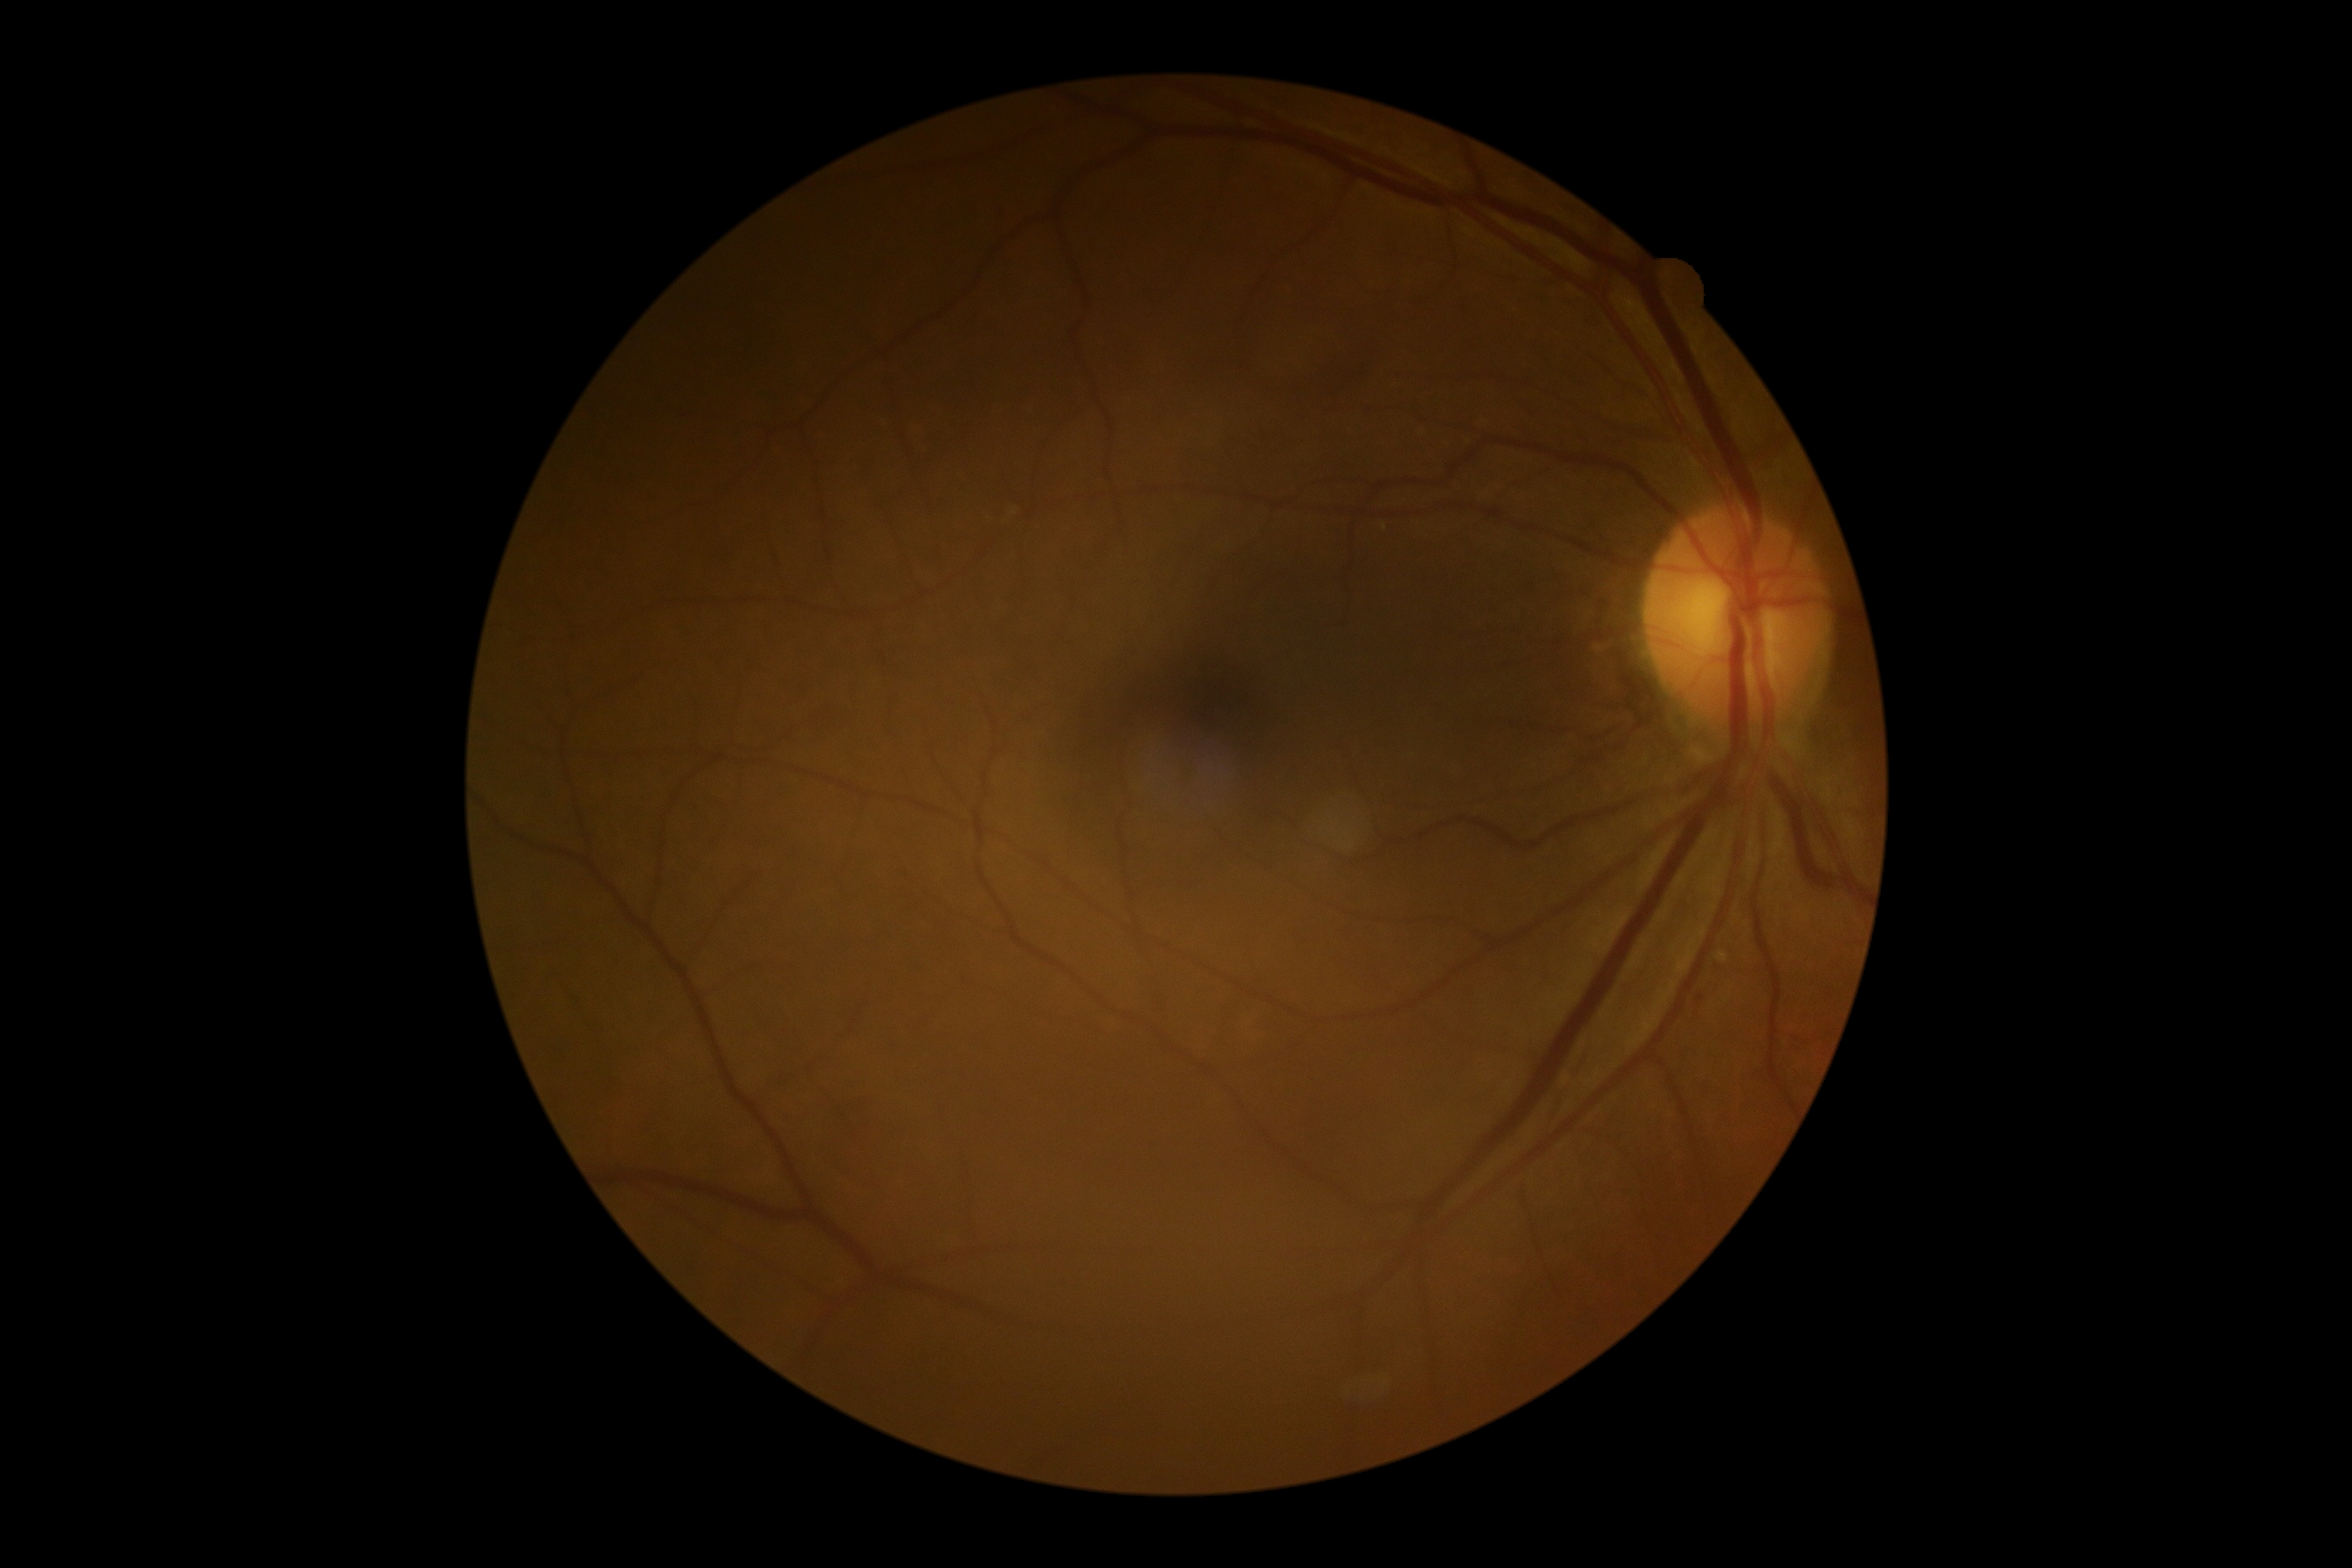
{
  "dr_grade": "1 (mild NPDR)"
}